1932 x 1932 pixels — 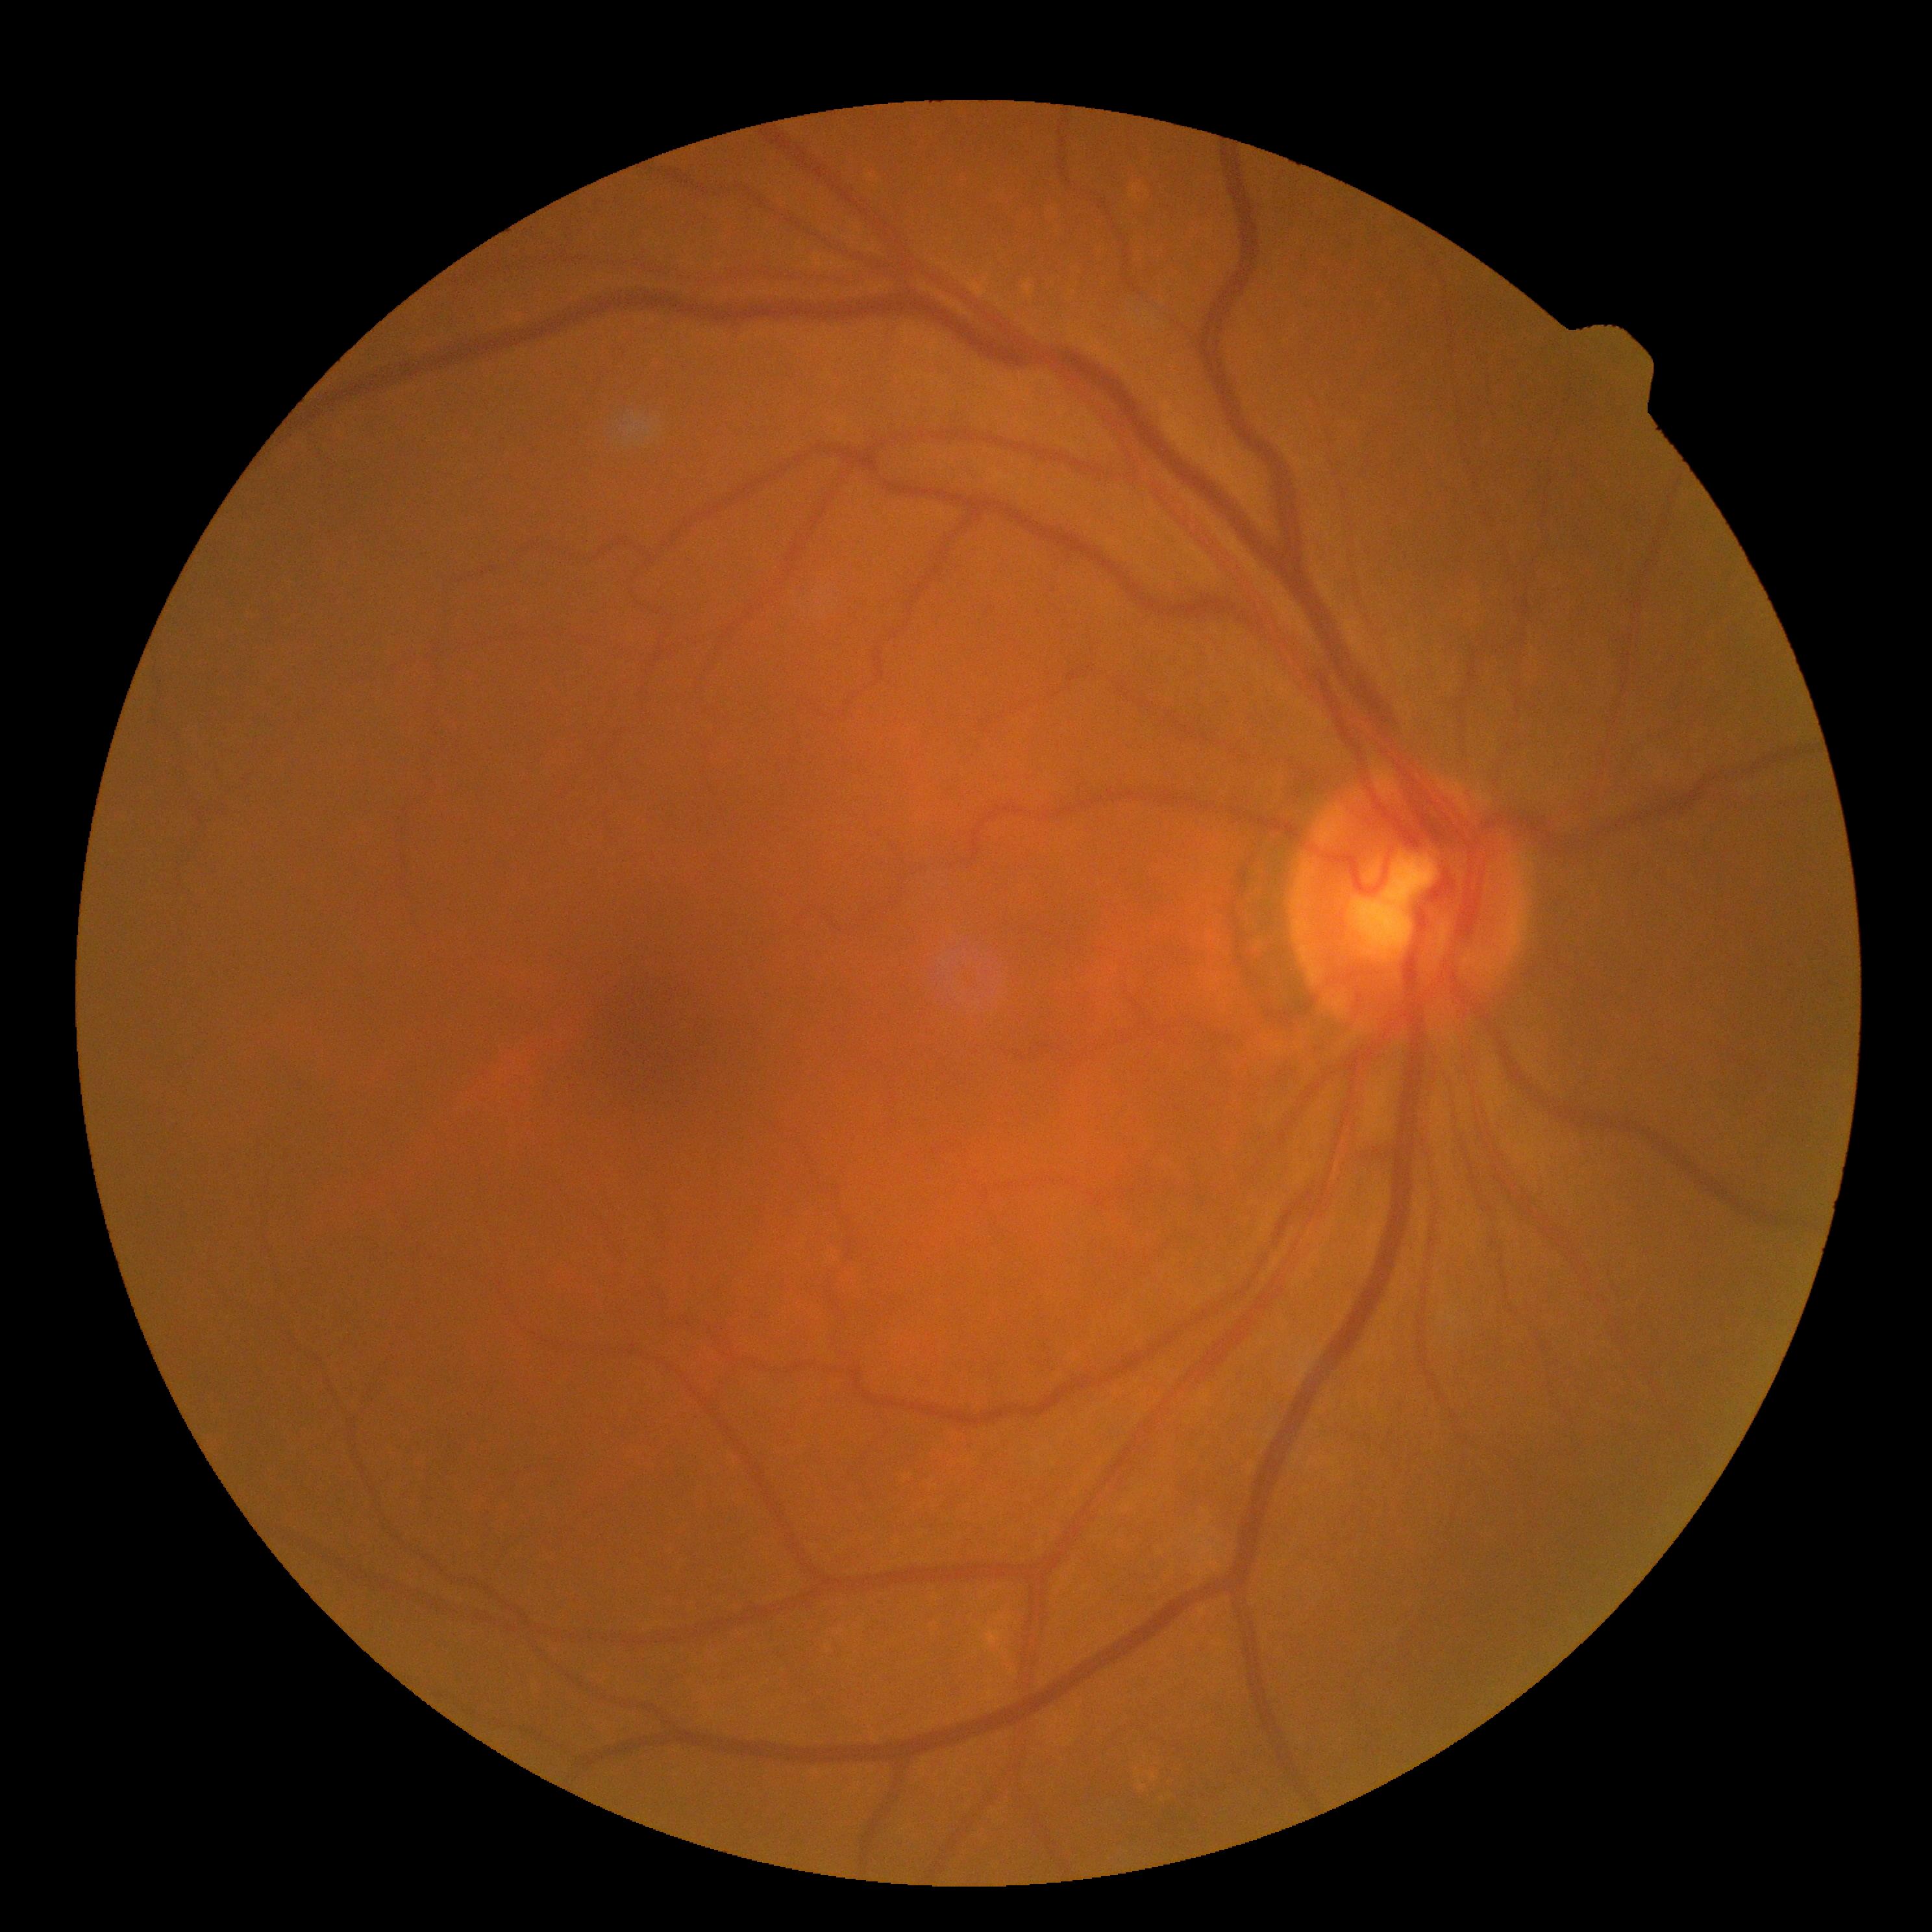
Annotations:
- retinopathy — 0
- DR impression — no apparent DR